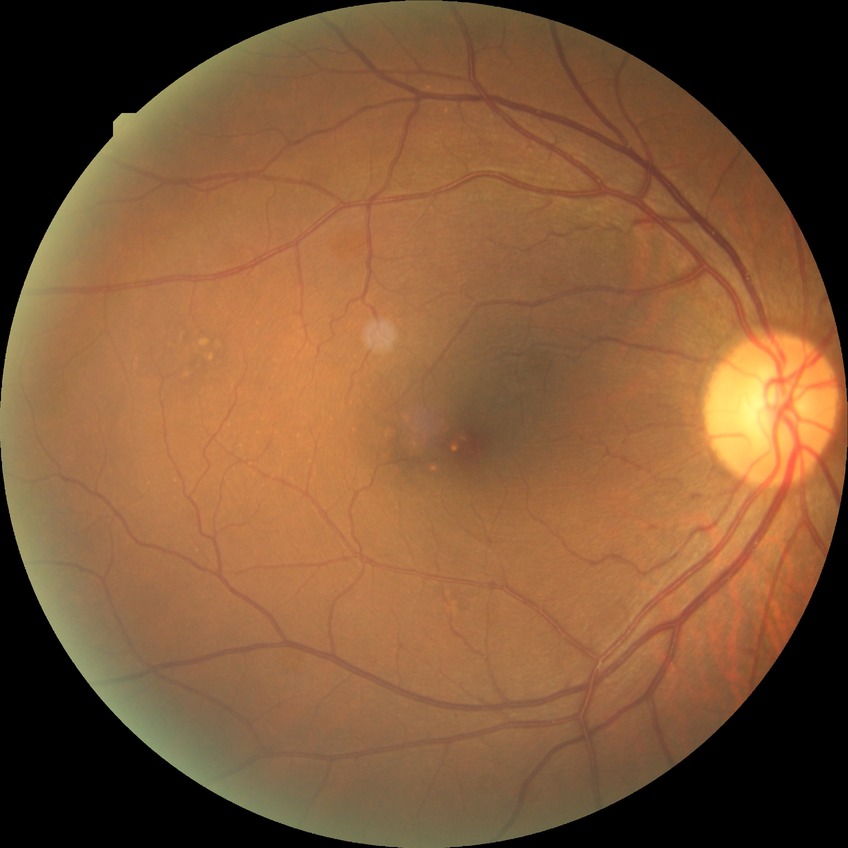 {
  "davis_grade": "no diabetic retinopathy (NDR)"
}